FOV: 45 degrees · camera: NIDEK AFC-230 · no pharmacologic dilation
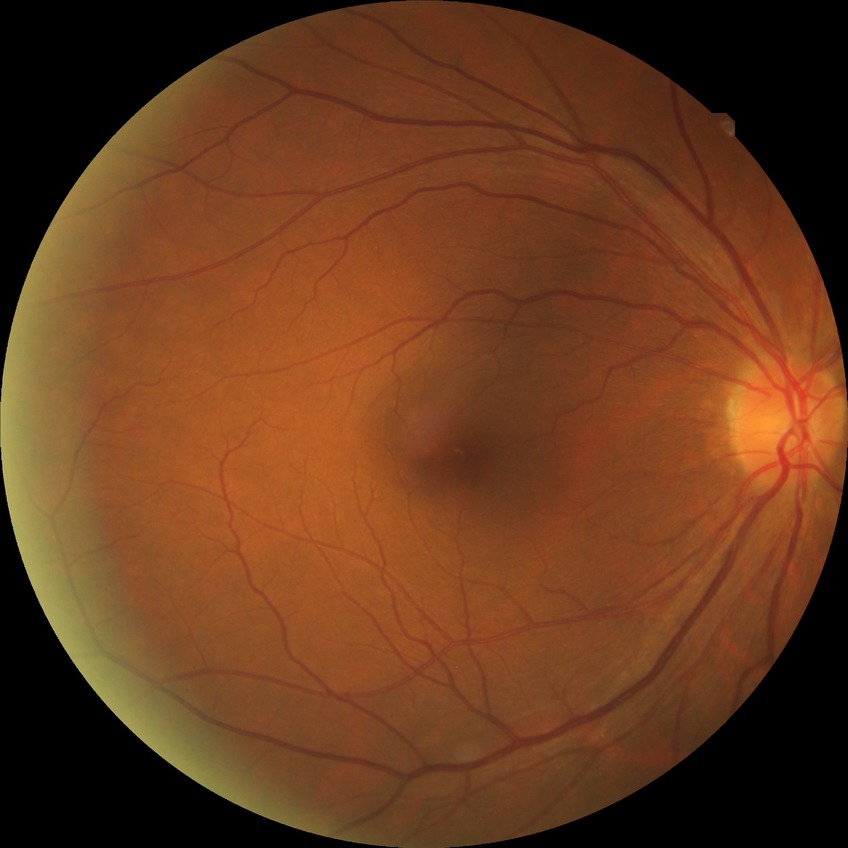 Diabetic retinopathy (DR) is simple diabetic retinopathy (SDR).